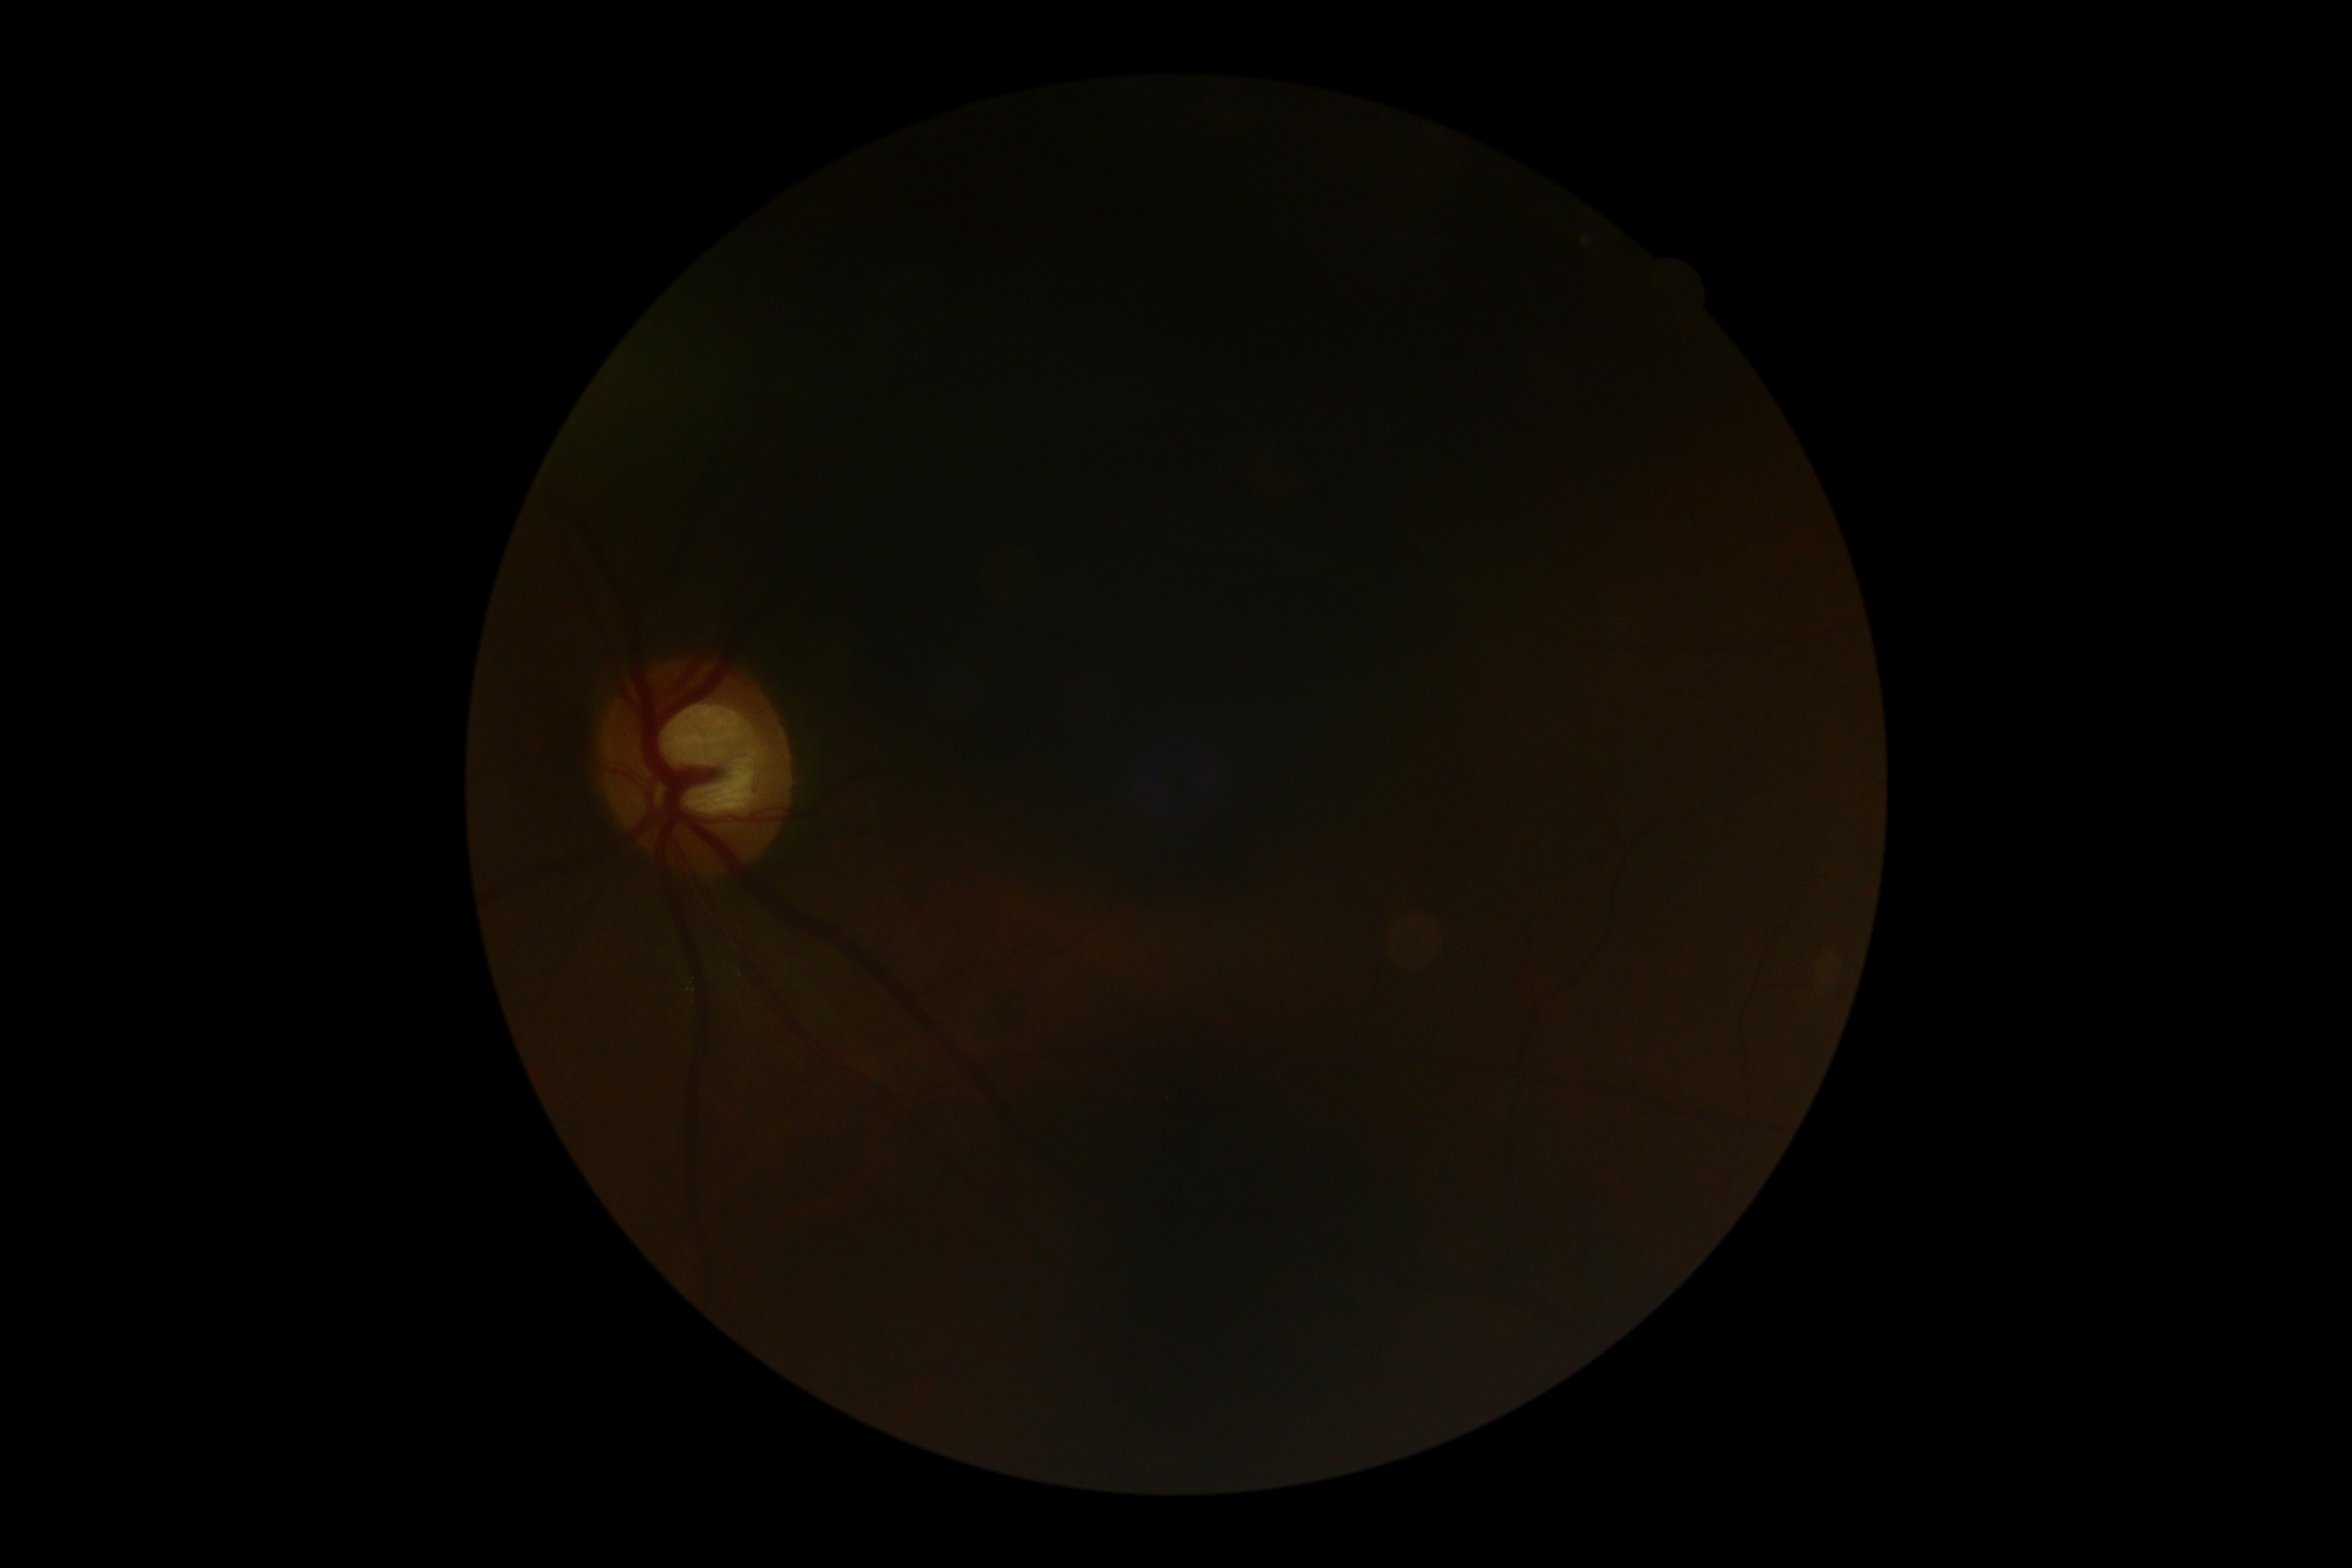

DR stage is ungradable due to poor image quality.